848 by 848 pixels · posterior pole photograph — 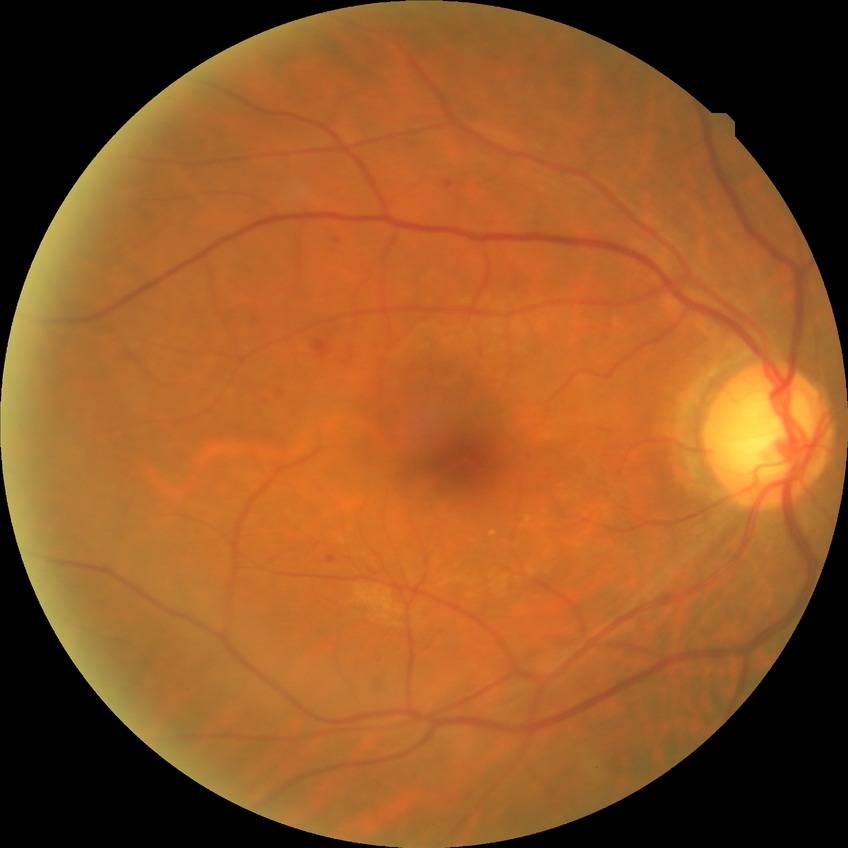 Diabetic retinopathy (DR) is simple diabetic retinopathy (SDR).